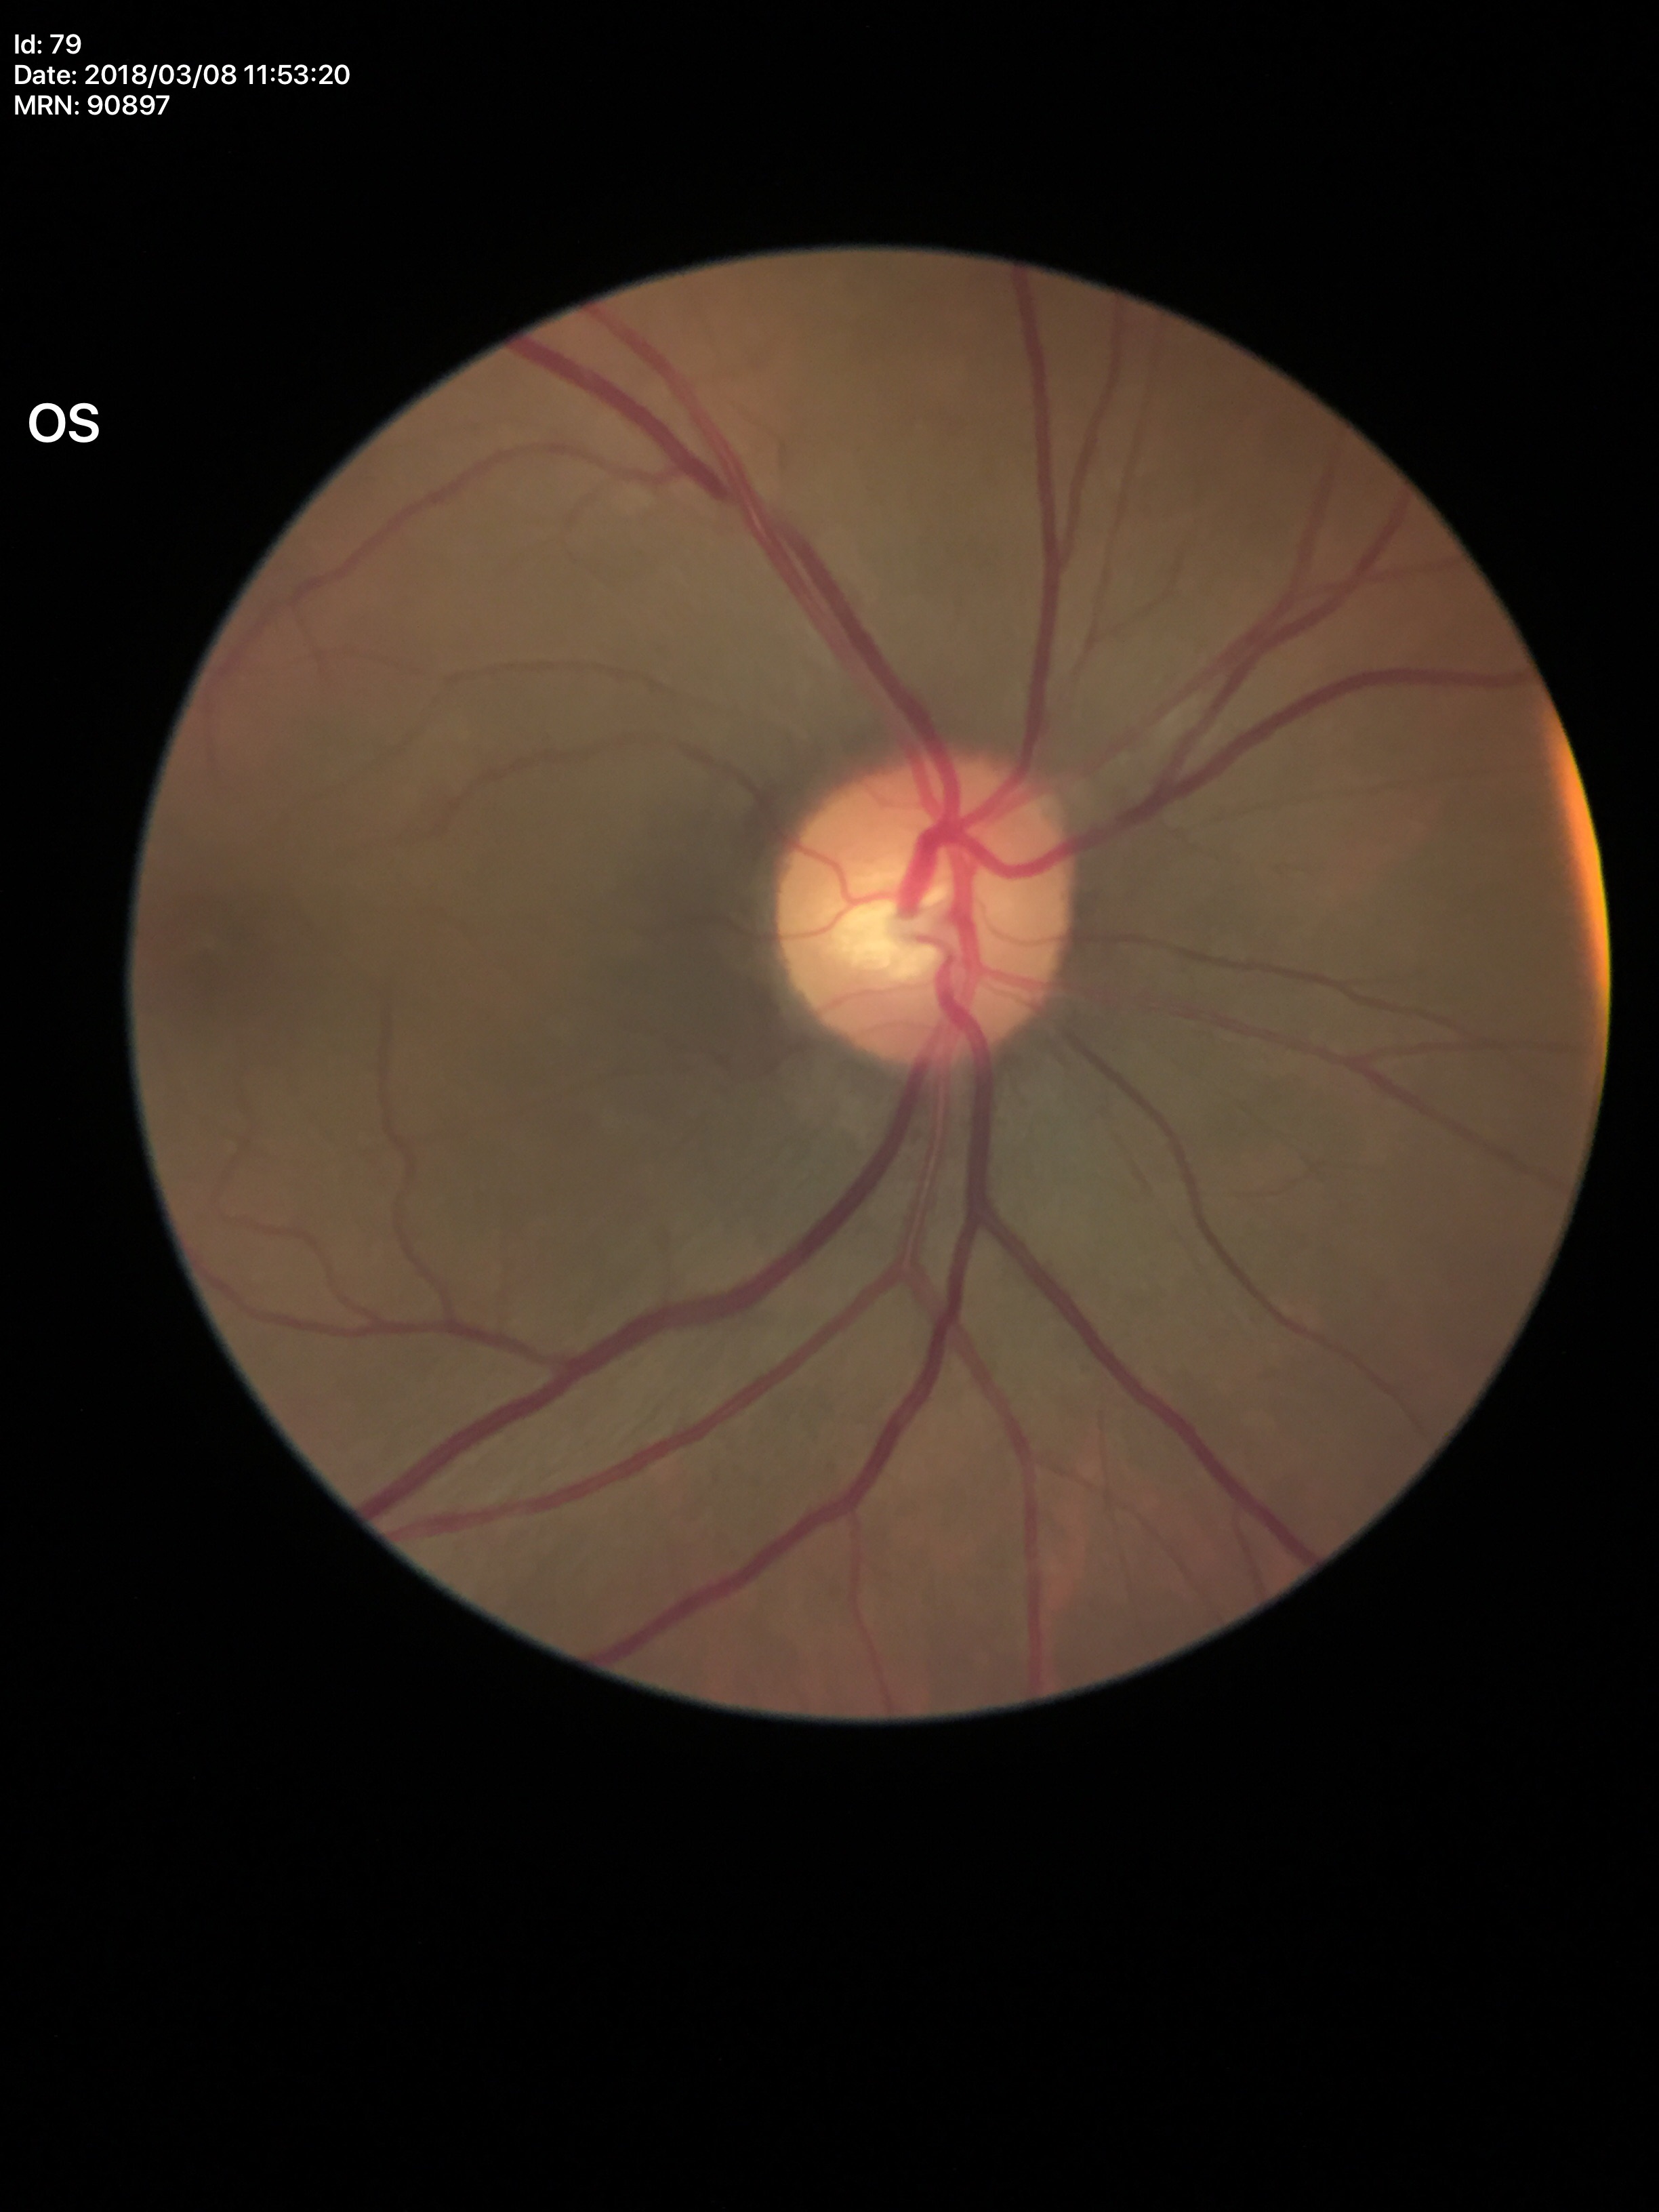
horizontal cup-to-disc ratio: 0.51 | vertical CDR: 0.48 | Glaucoma screening impression: negative